Acquired with a NIDEK AFC-230; 848 x 848 pixels.
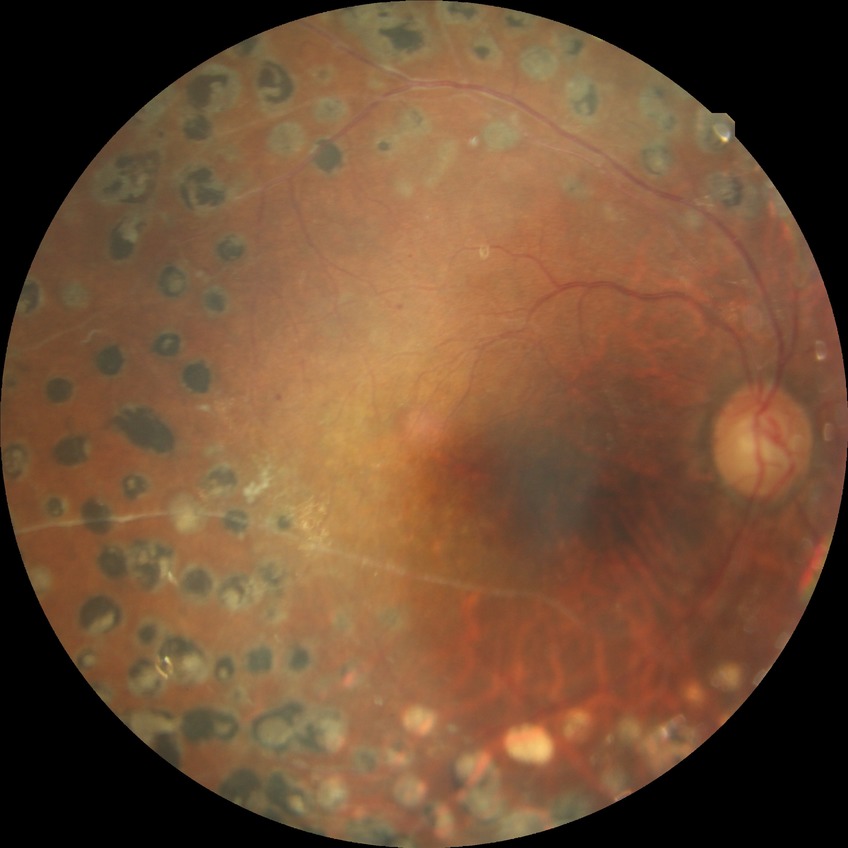 davis_grade: PDR